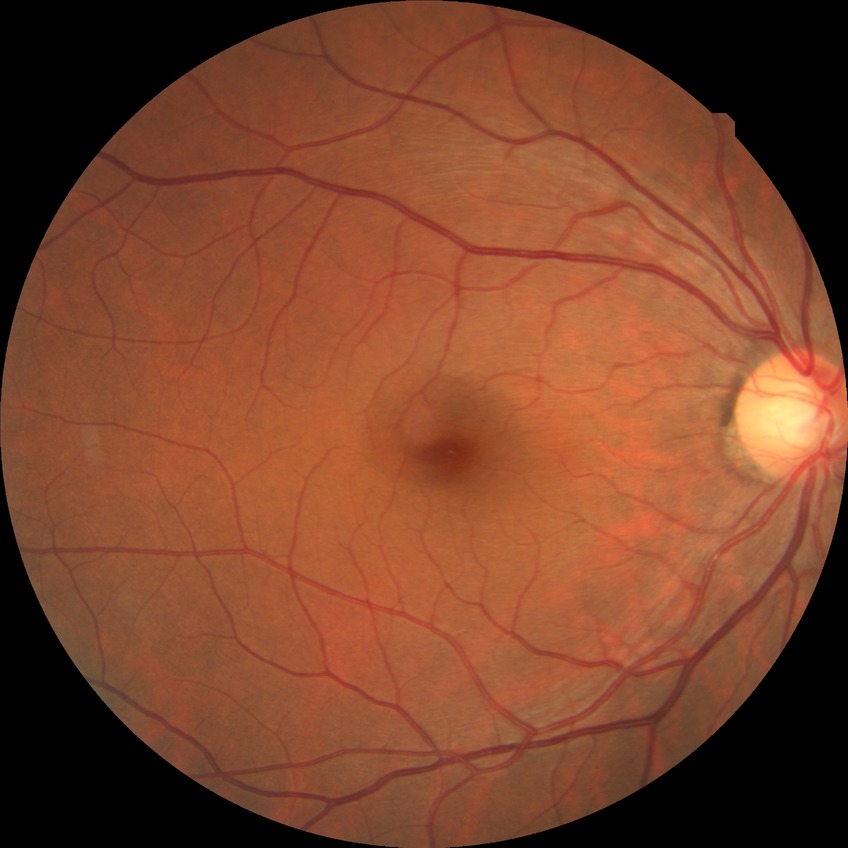
Diabetic retinopathy (DR) is no diabetic retinopathy (NDR).